2352 x 1568 pixels · color fundus photograph · 45-degree field of view:
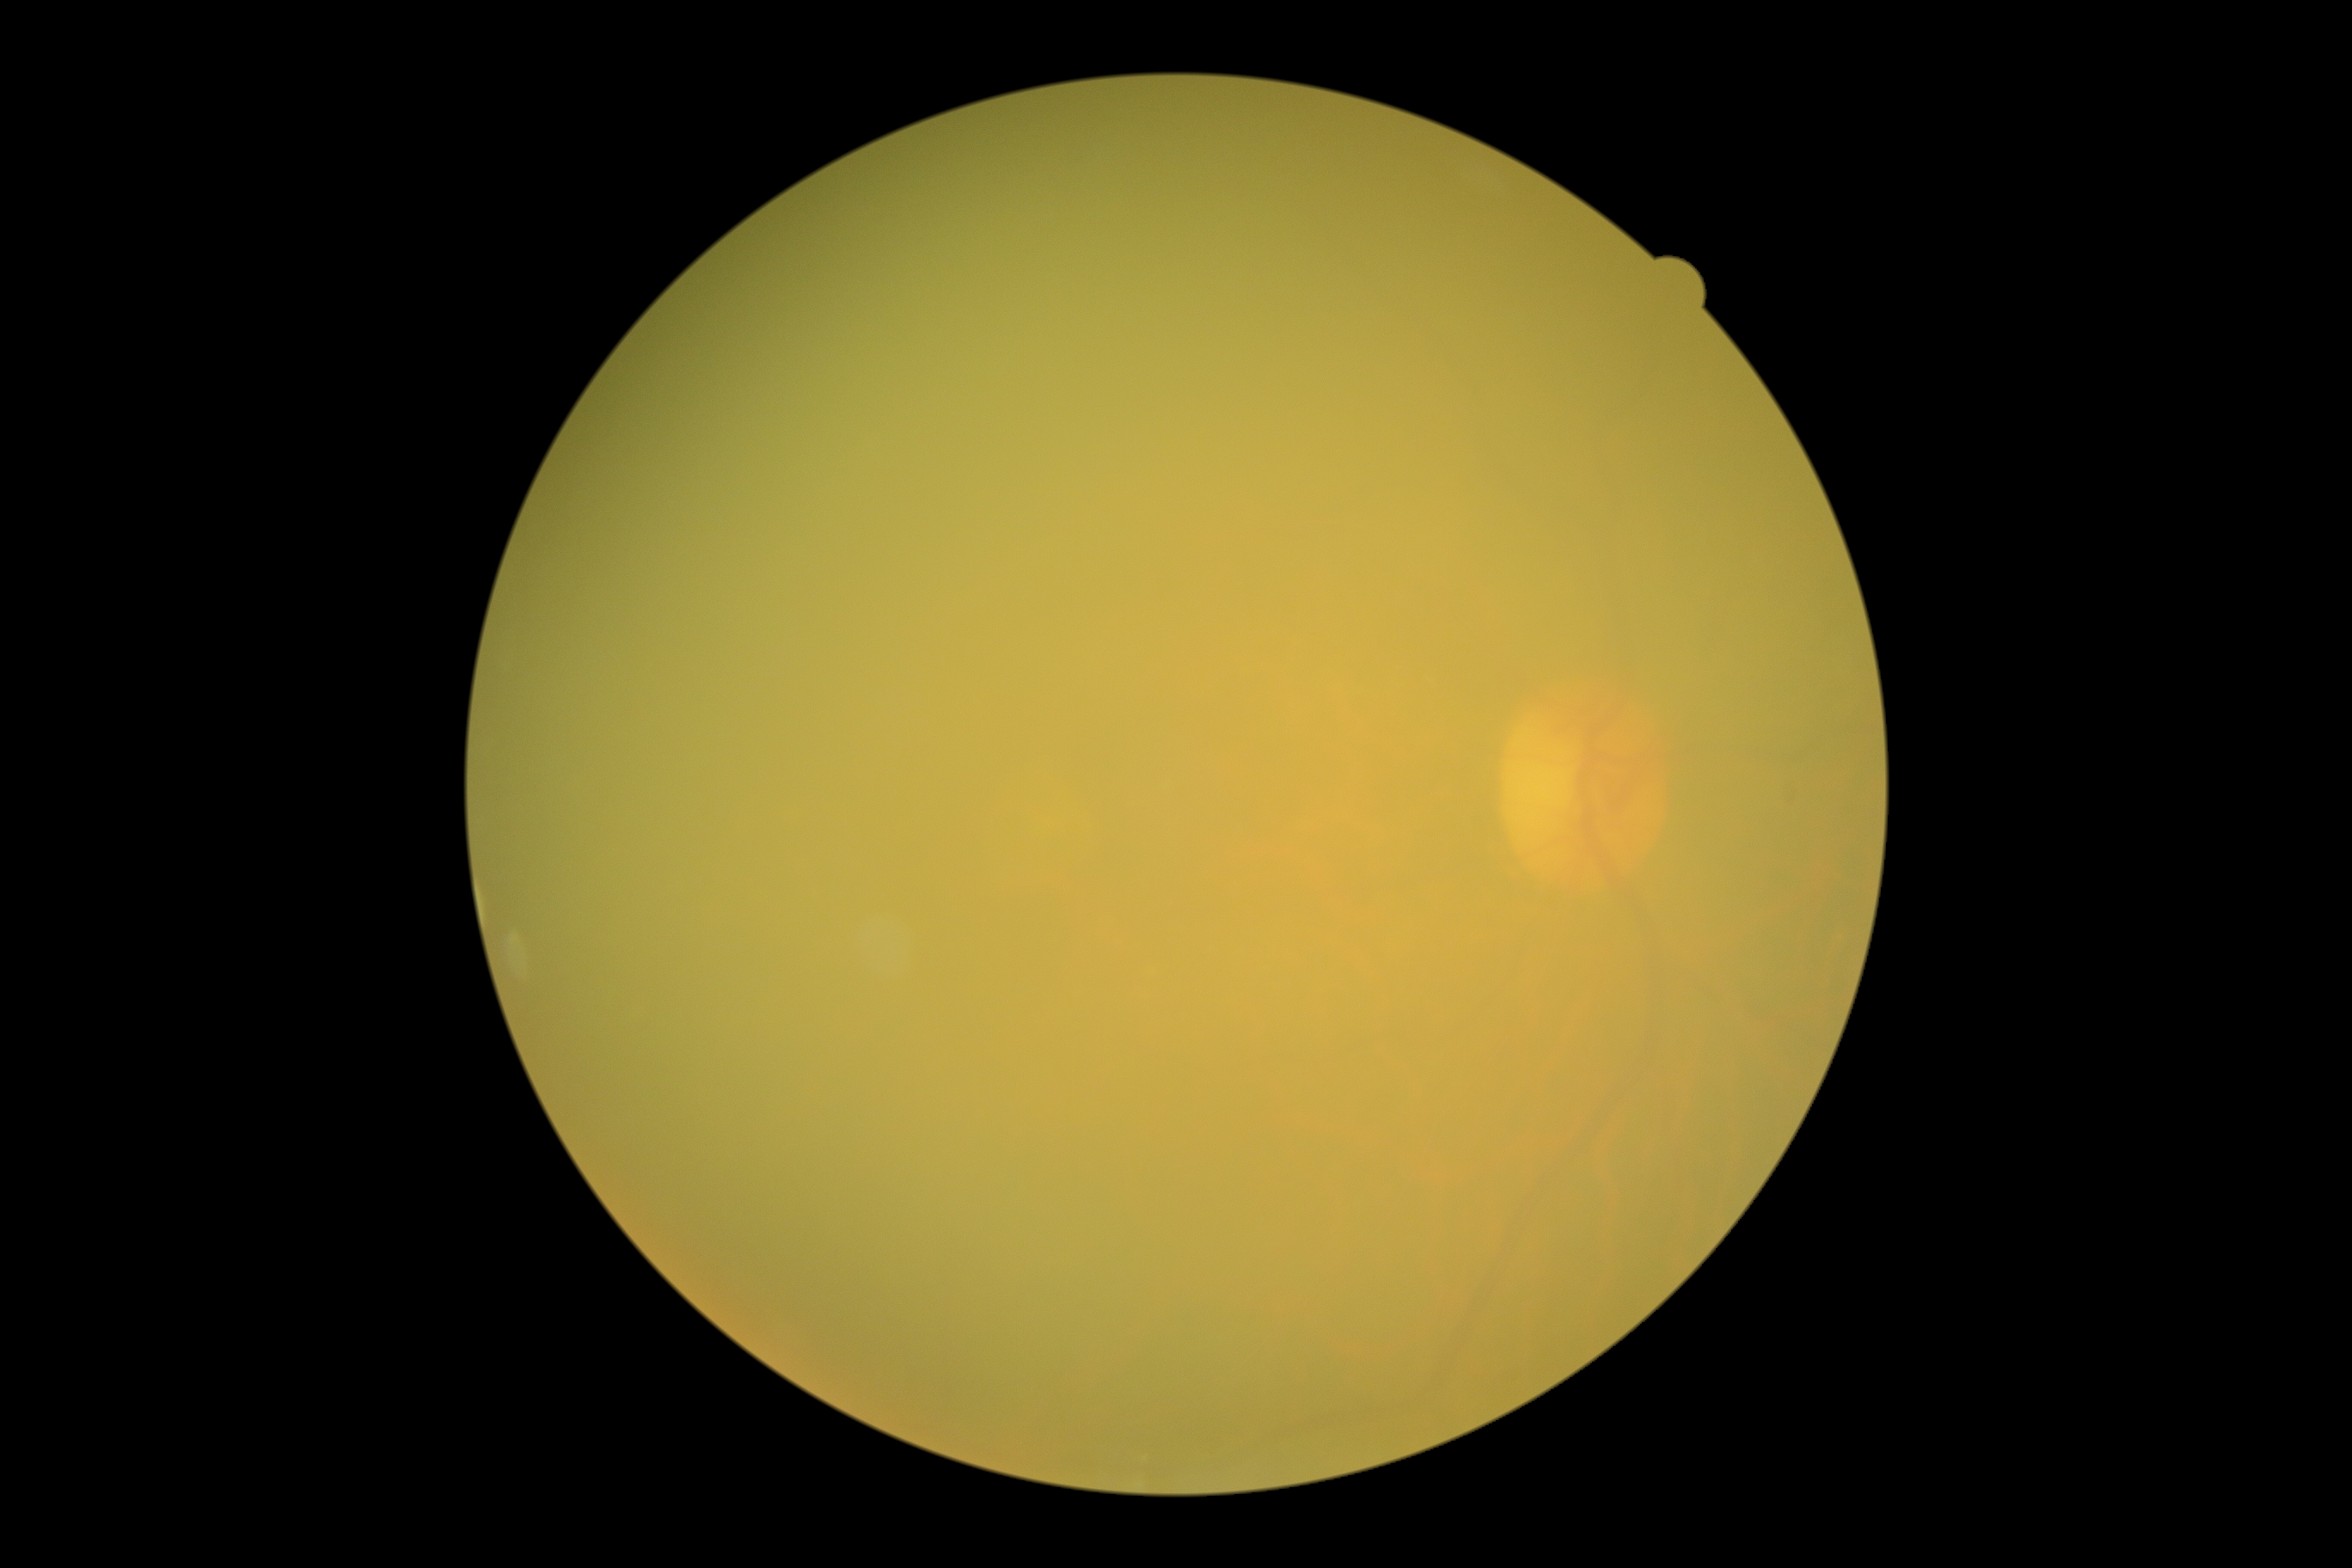
DR grade is ungradable due to poor image quality.